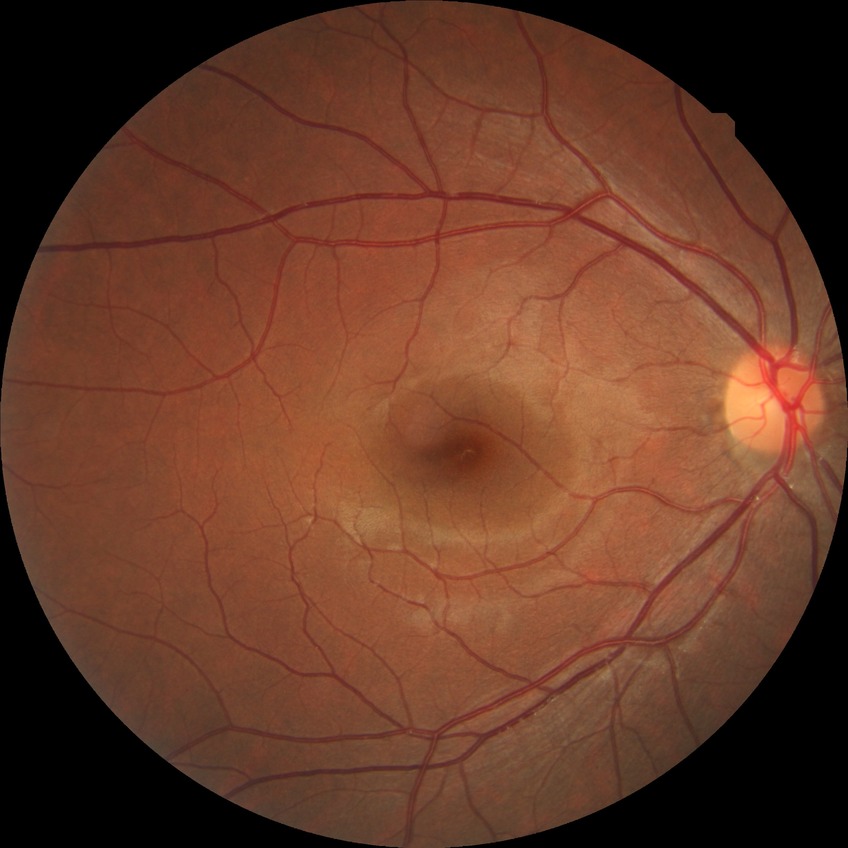

Modified Davis classification is no diabetic retinopathy.